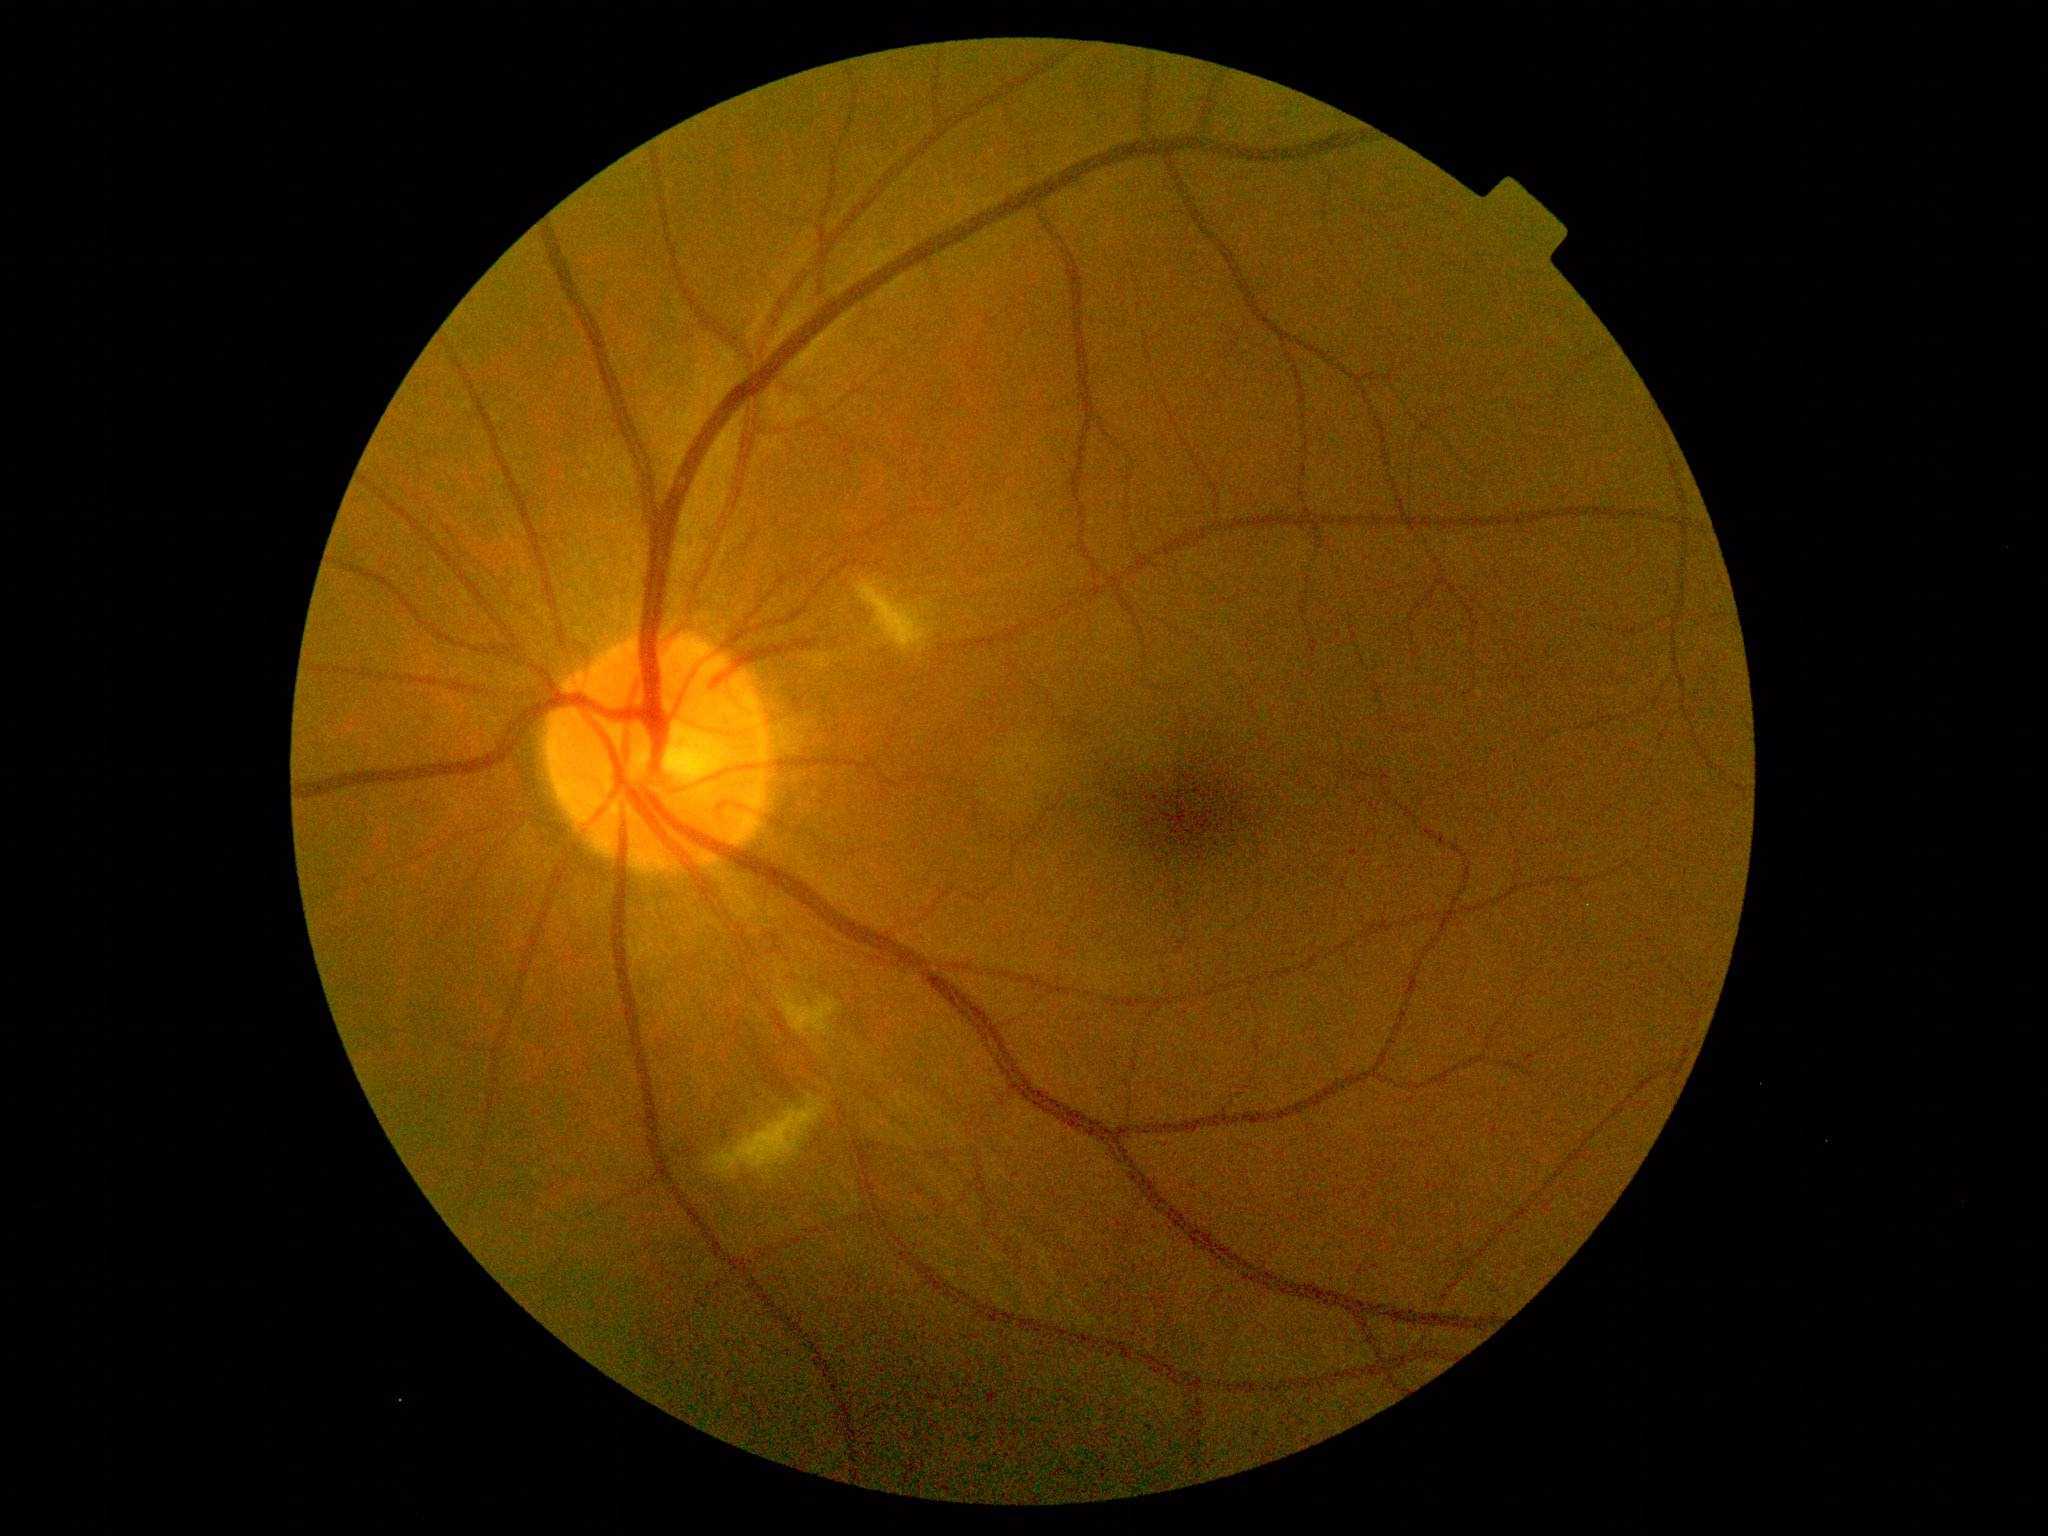

diabetic retinopathy = grade 2 (moderate NPDR); DR class = non-proliferative diabetic retinopathy.